Retinal fundus photograph; 2089x1764px
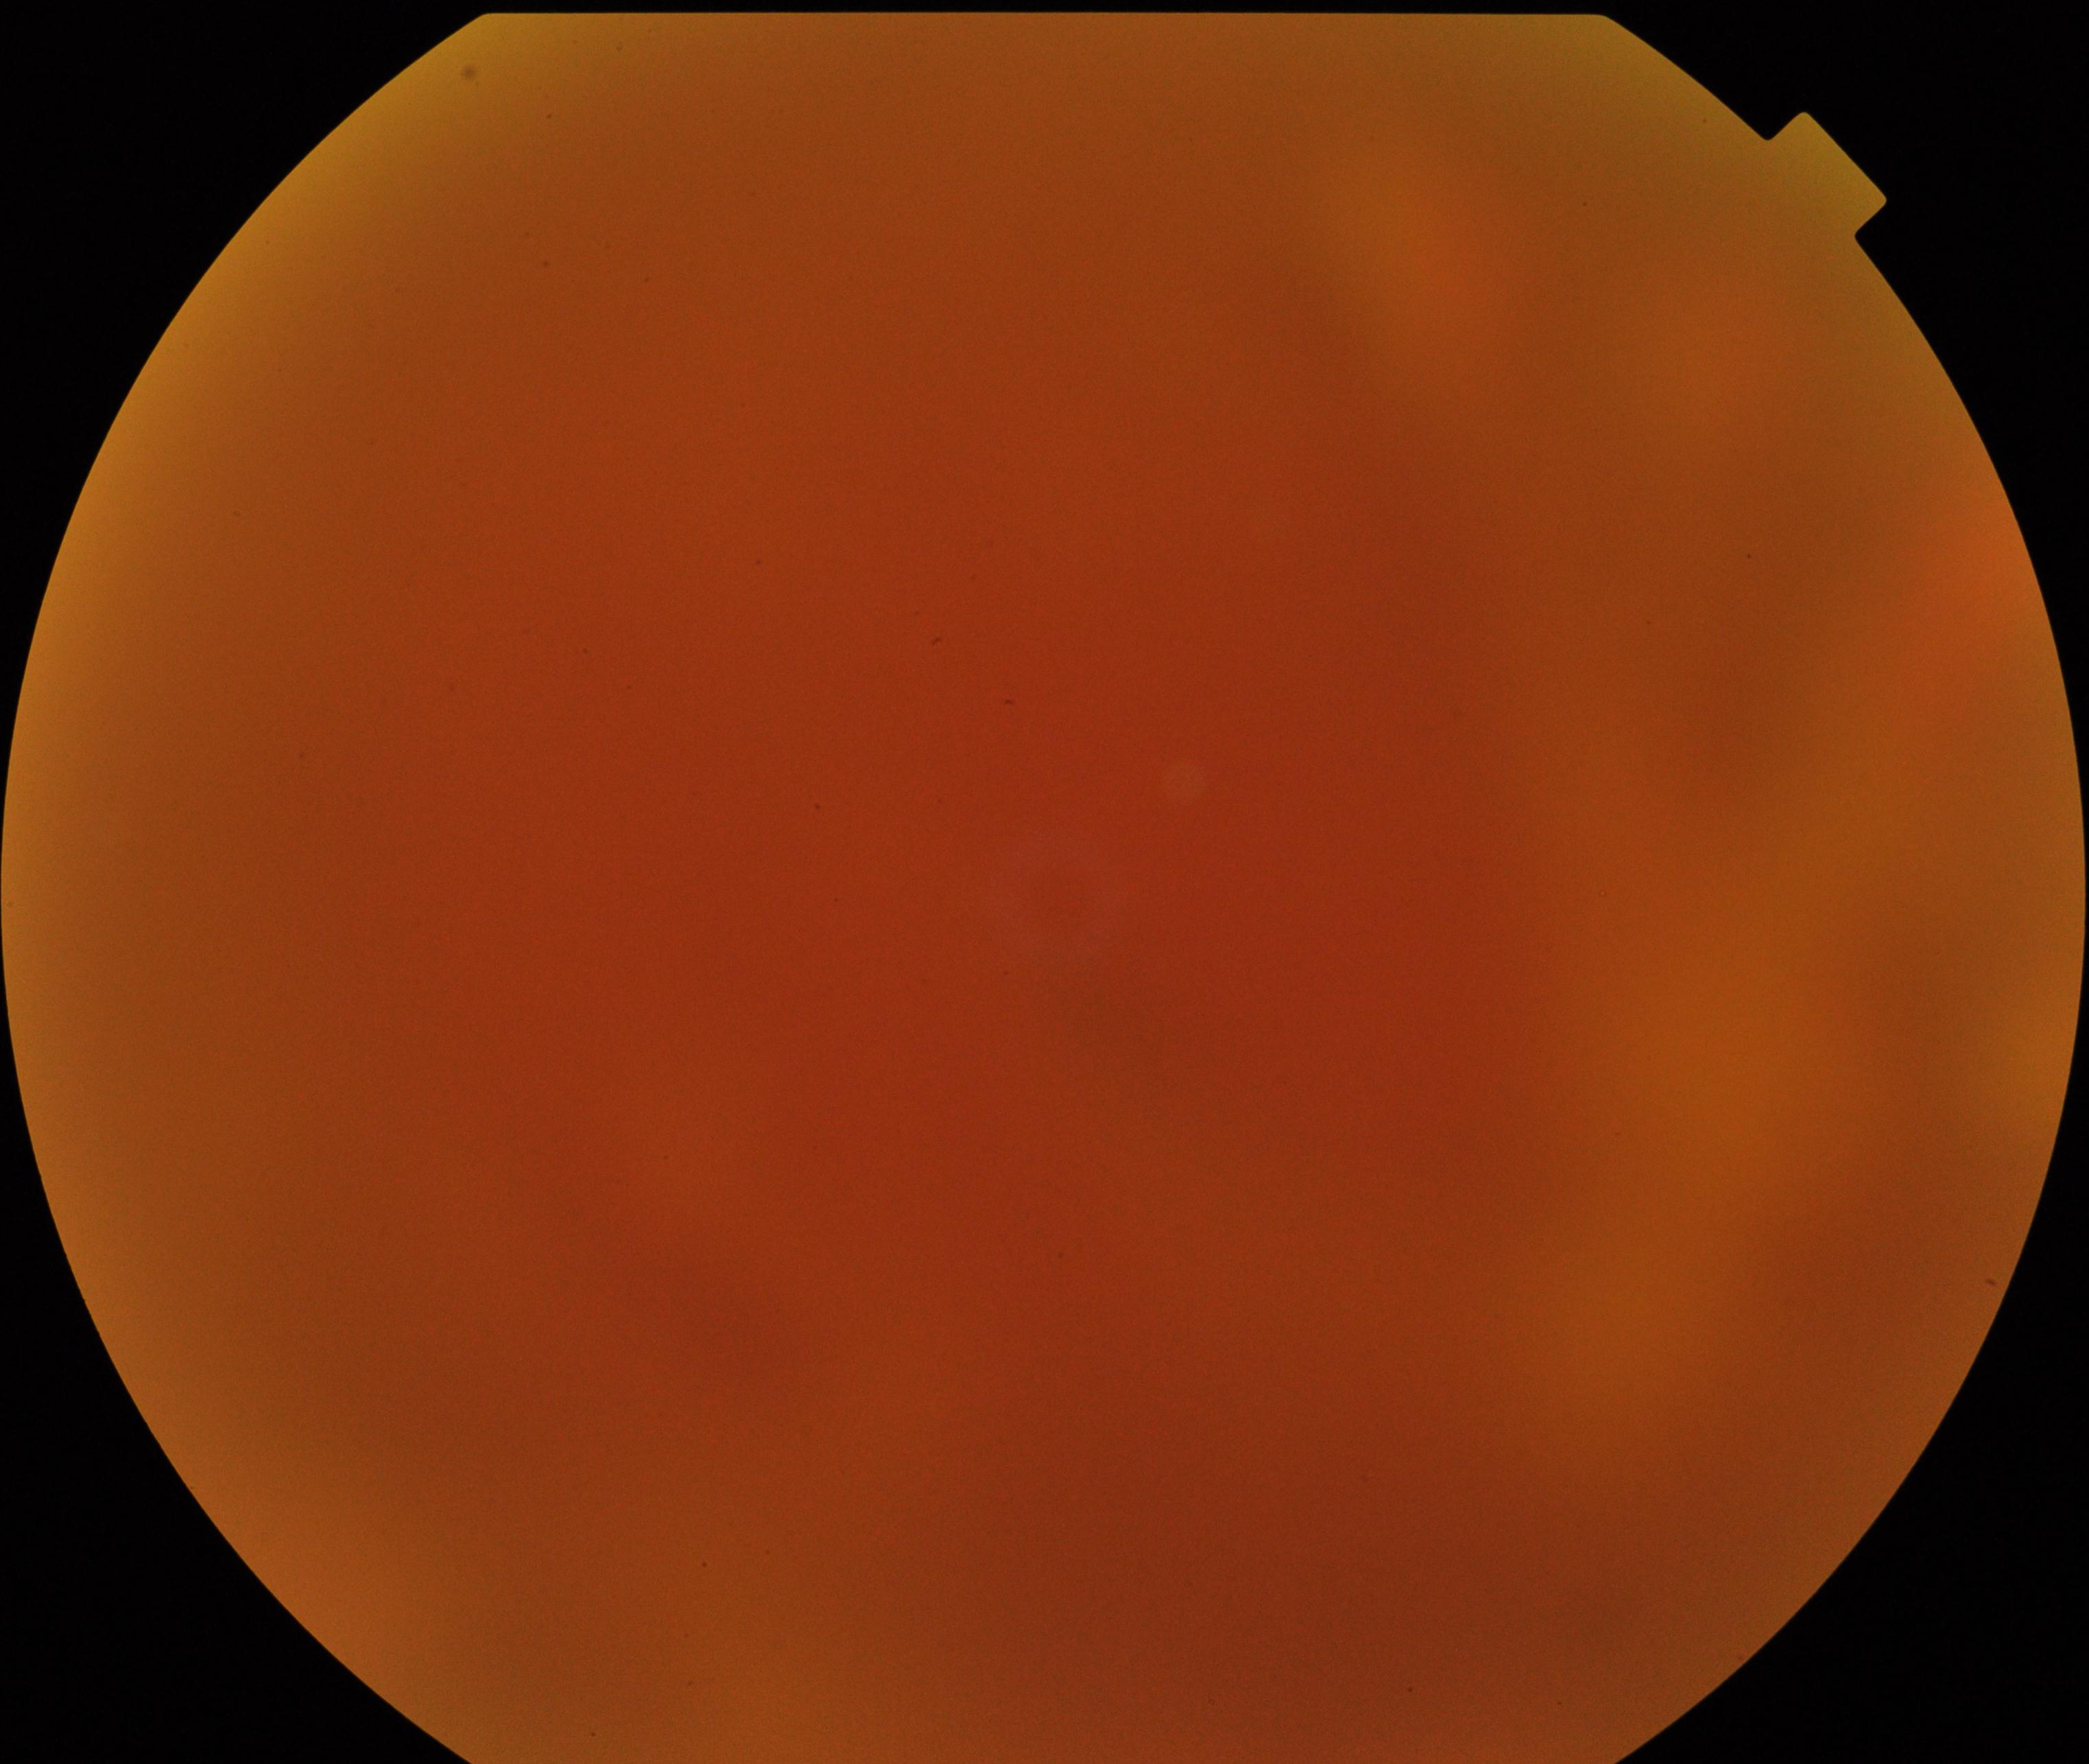

Image quality is poor; more than half the field is obscured. No evidence of proliferative diabetic retinopathy.